Autorefraction: +1.75 -0.75 x 95. Central corneal thickness: 534 µm. Axial length (AL): 22.5 mm. Captured without pupil dilation.
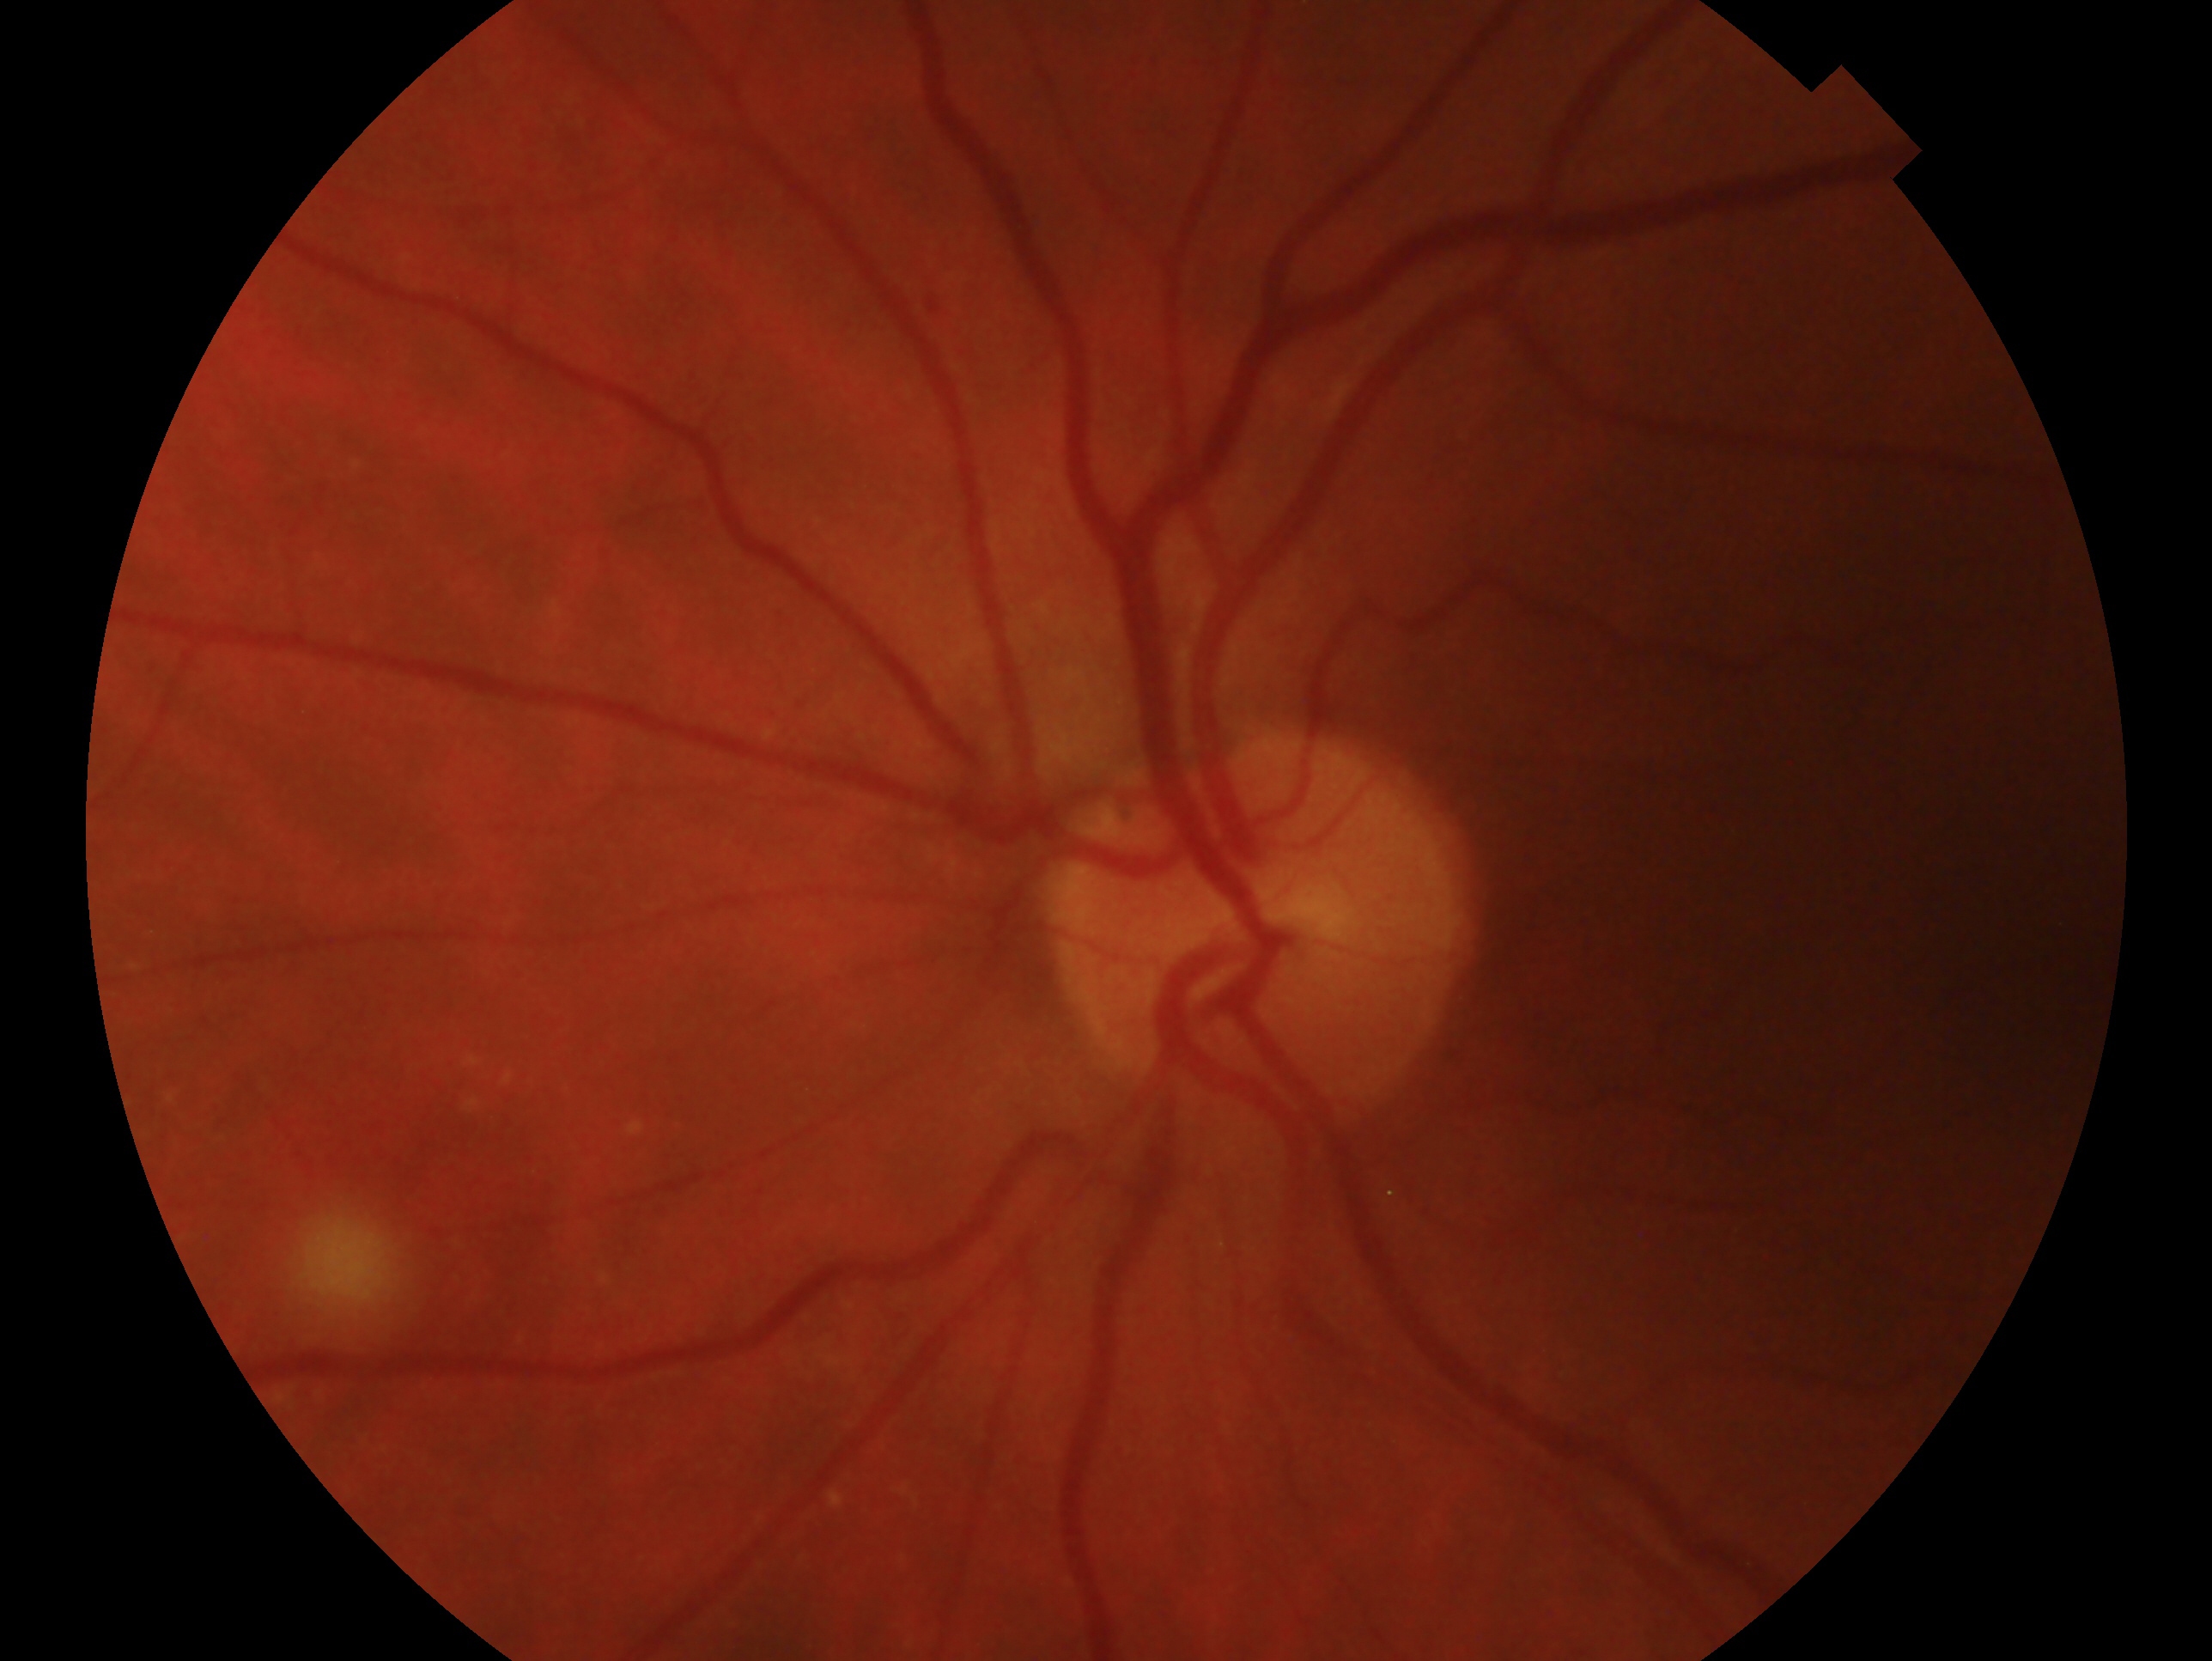

laterality: left eye, impression: no evidence of glaucoma.